1240 x 1240 pixels; Phoenix ICON wide-field infant fundus image
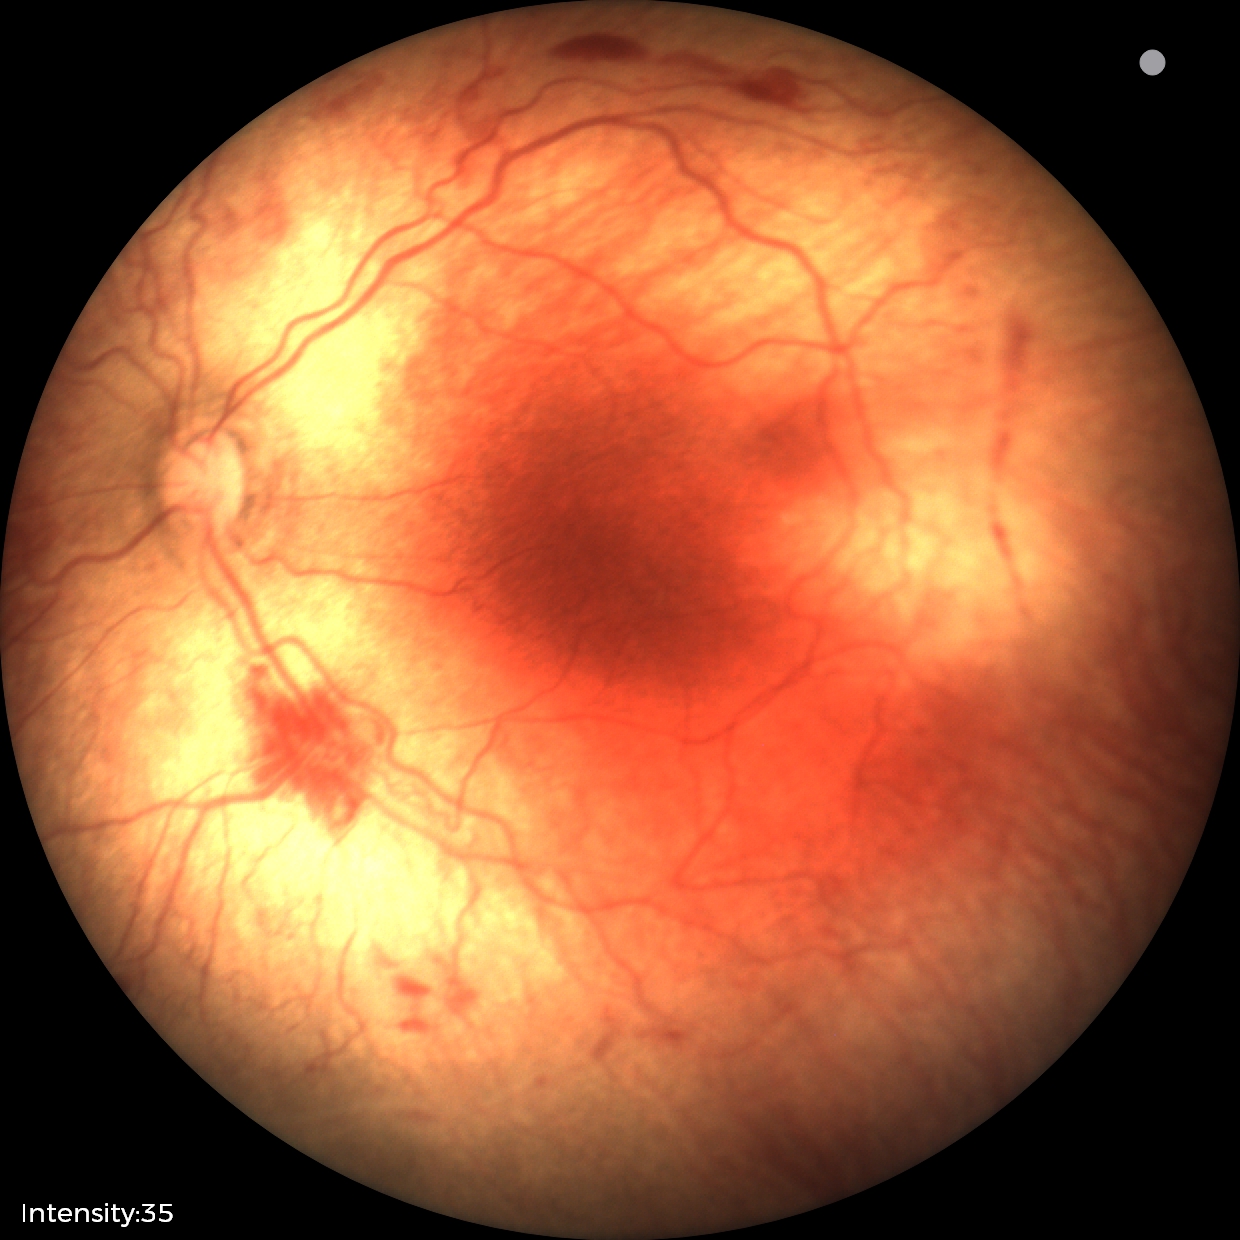

Diagnosis = retinopathy of prematurity (ROP) stage 2.